848 x 848 pixels — 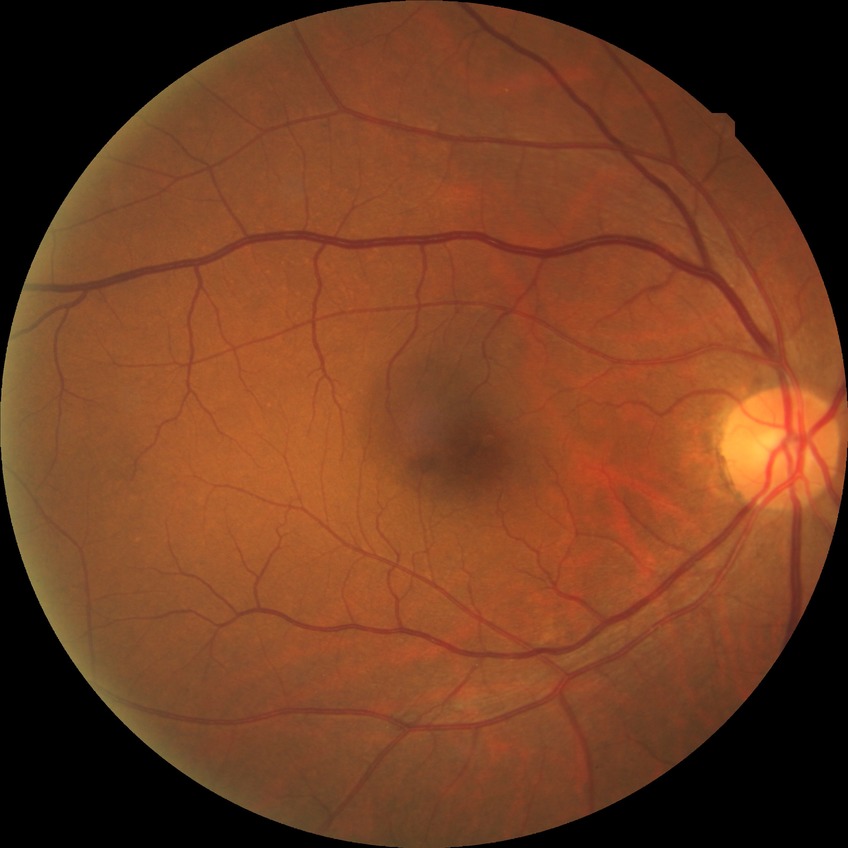
- diabetic retinopathy (DR): NDR (no diabetic retinopathy)